45° field of view, acquired with a NIDEK AFC-230, nonmydriatic, diabetic retinopathy graded by the modified Davis classification, 848 x 848 pixels.
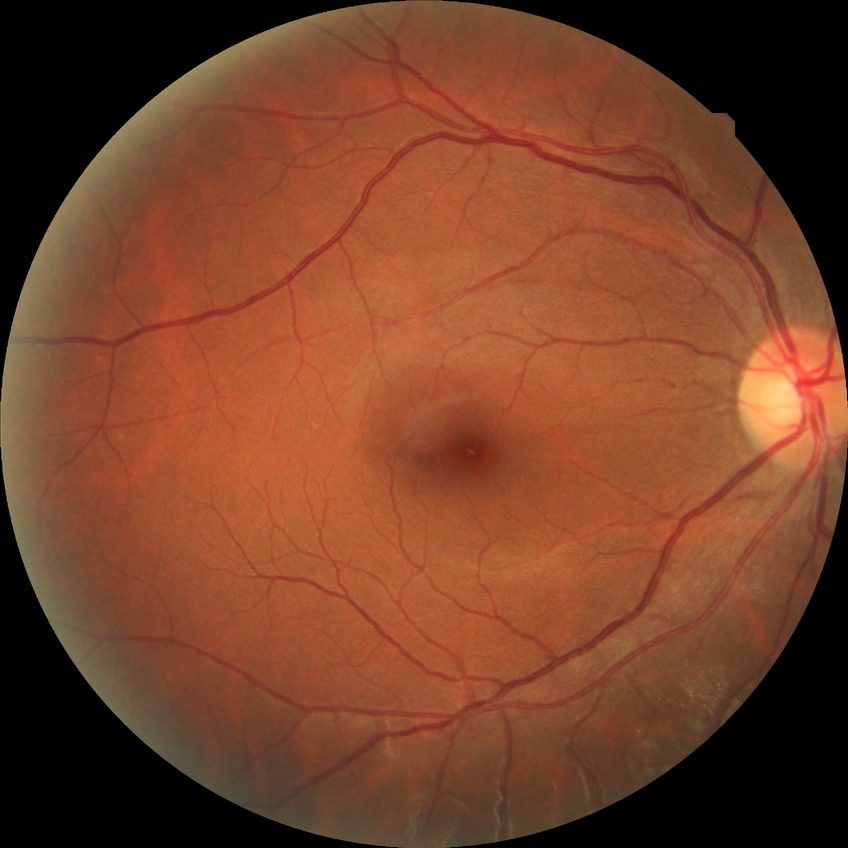 Retinopathy grade: no diabetic retinopathy.